45-degree field of view — 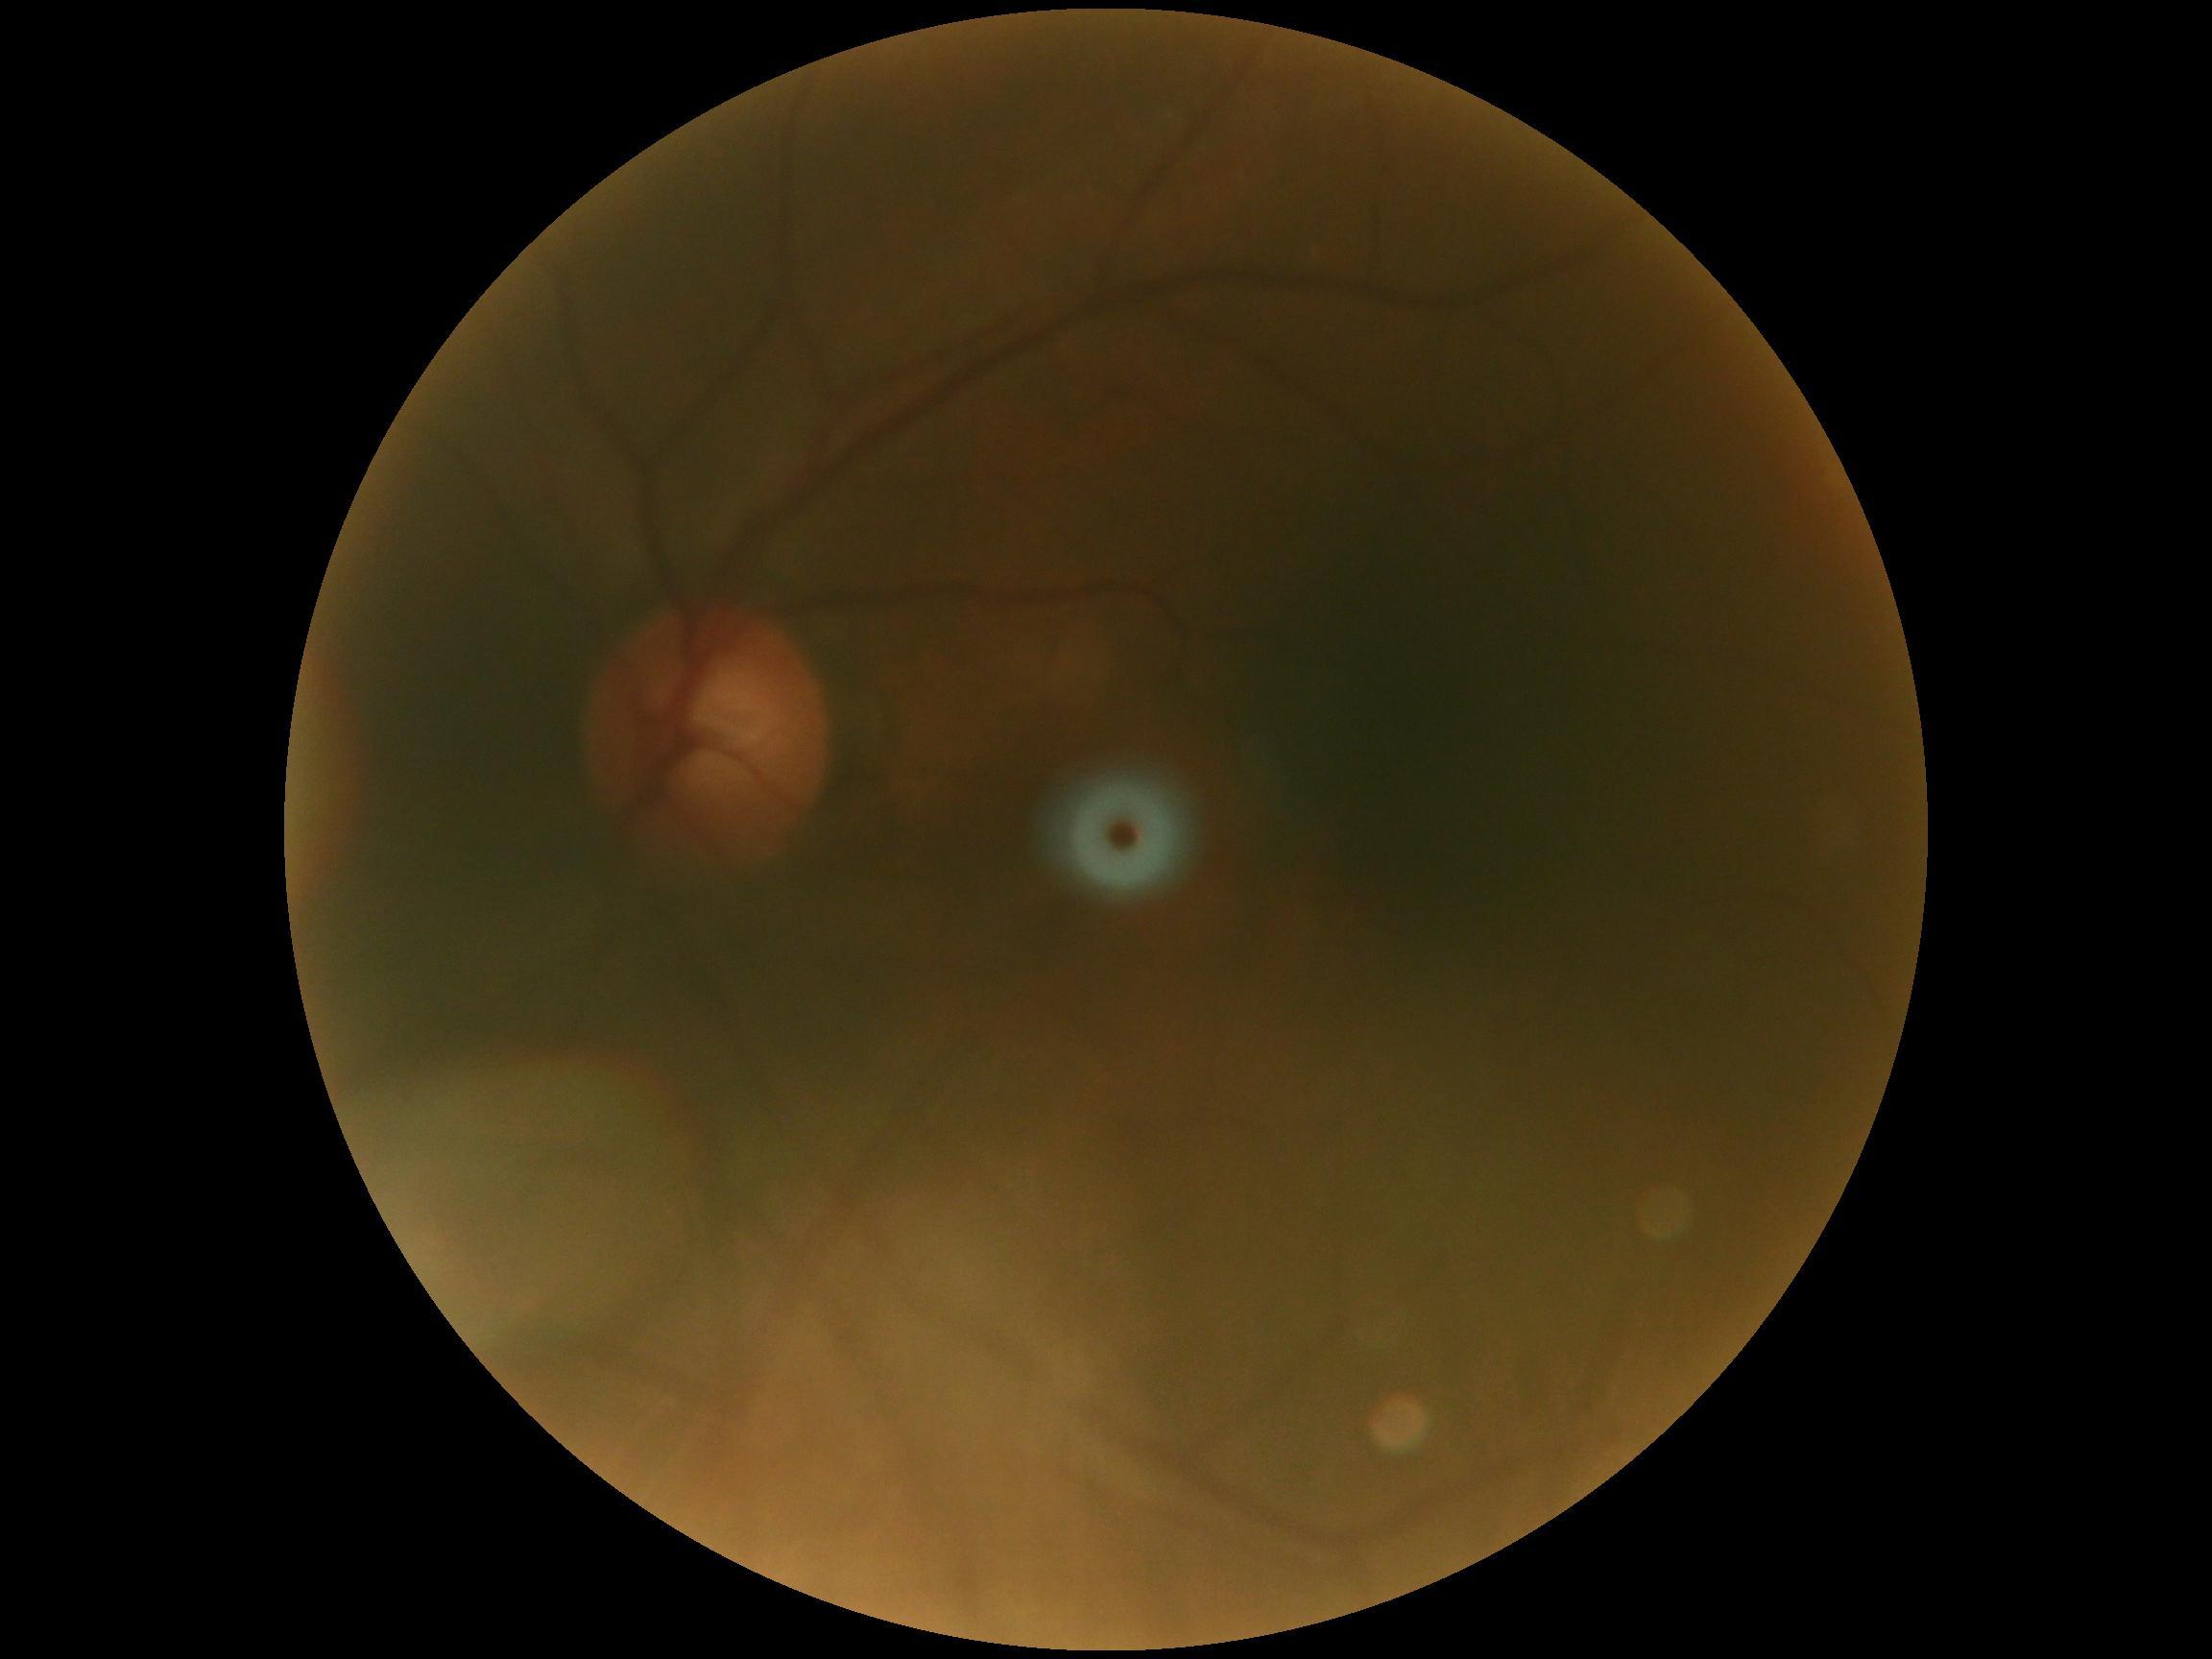
{"dr_grade": "grade 0 (no apparent retinopathy) — no visible signs of diabetic retinopathy", "dr_impression": "negative for DR"}